2368 x 1568 pixels: 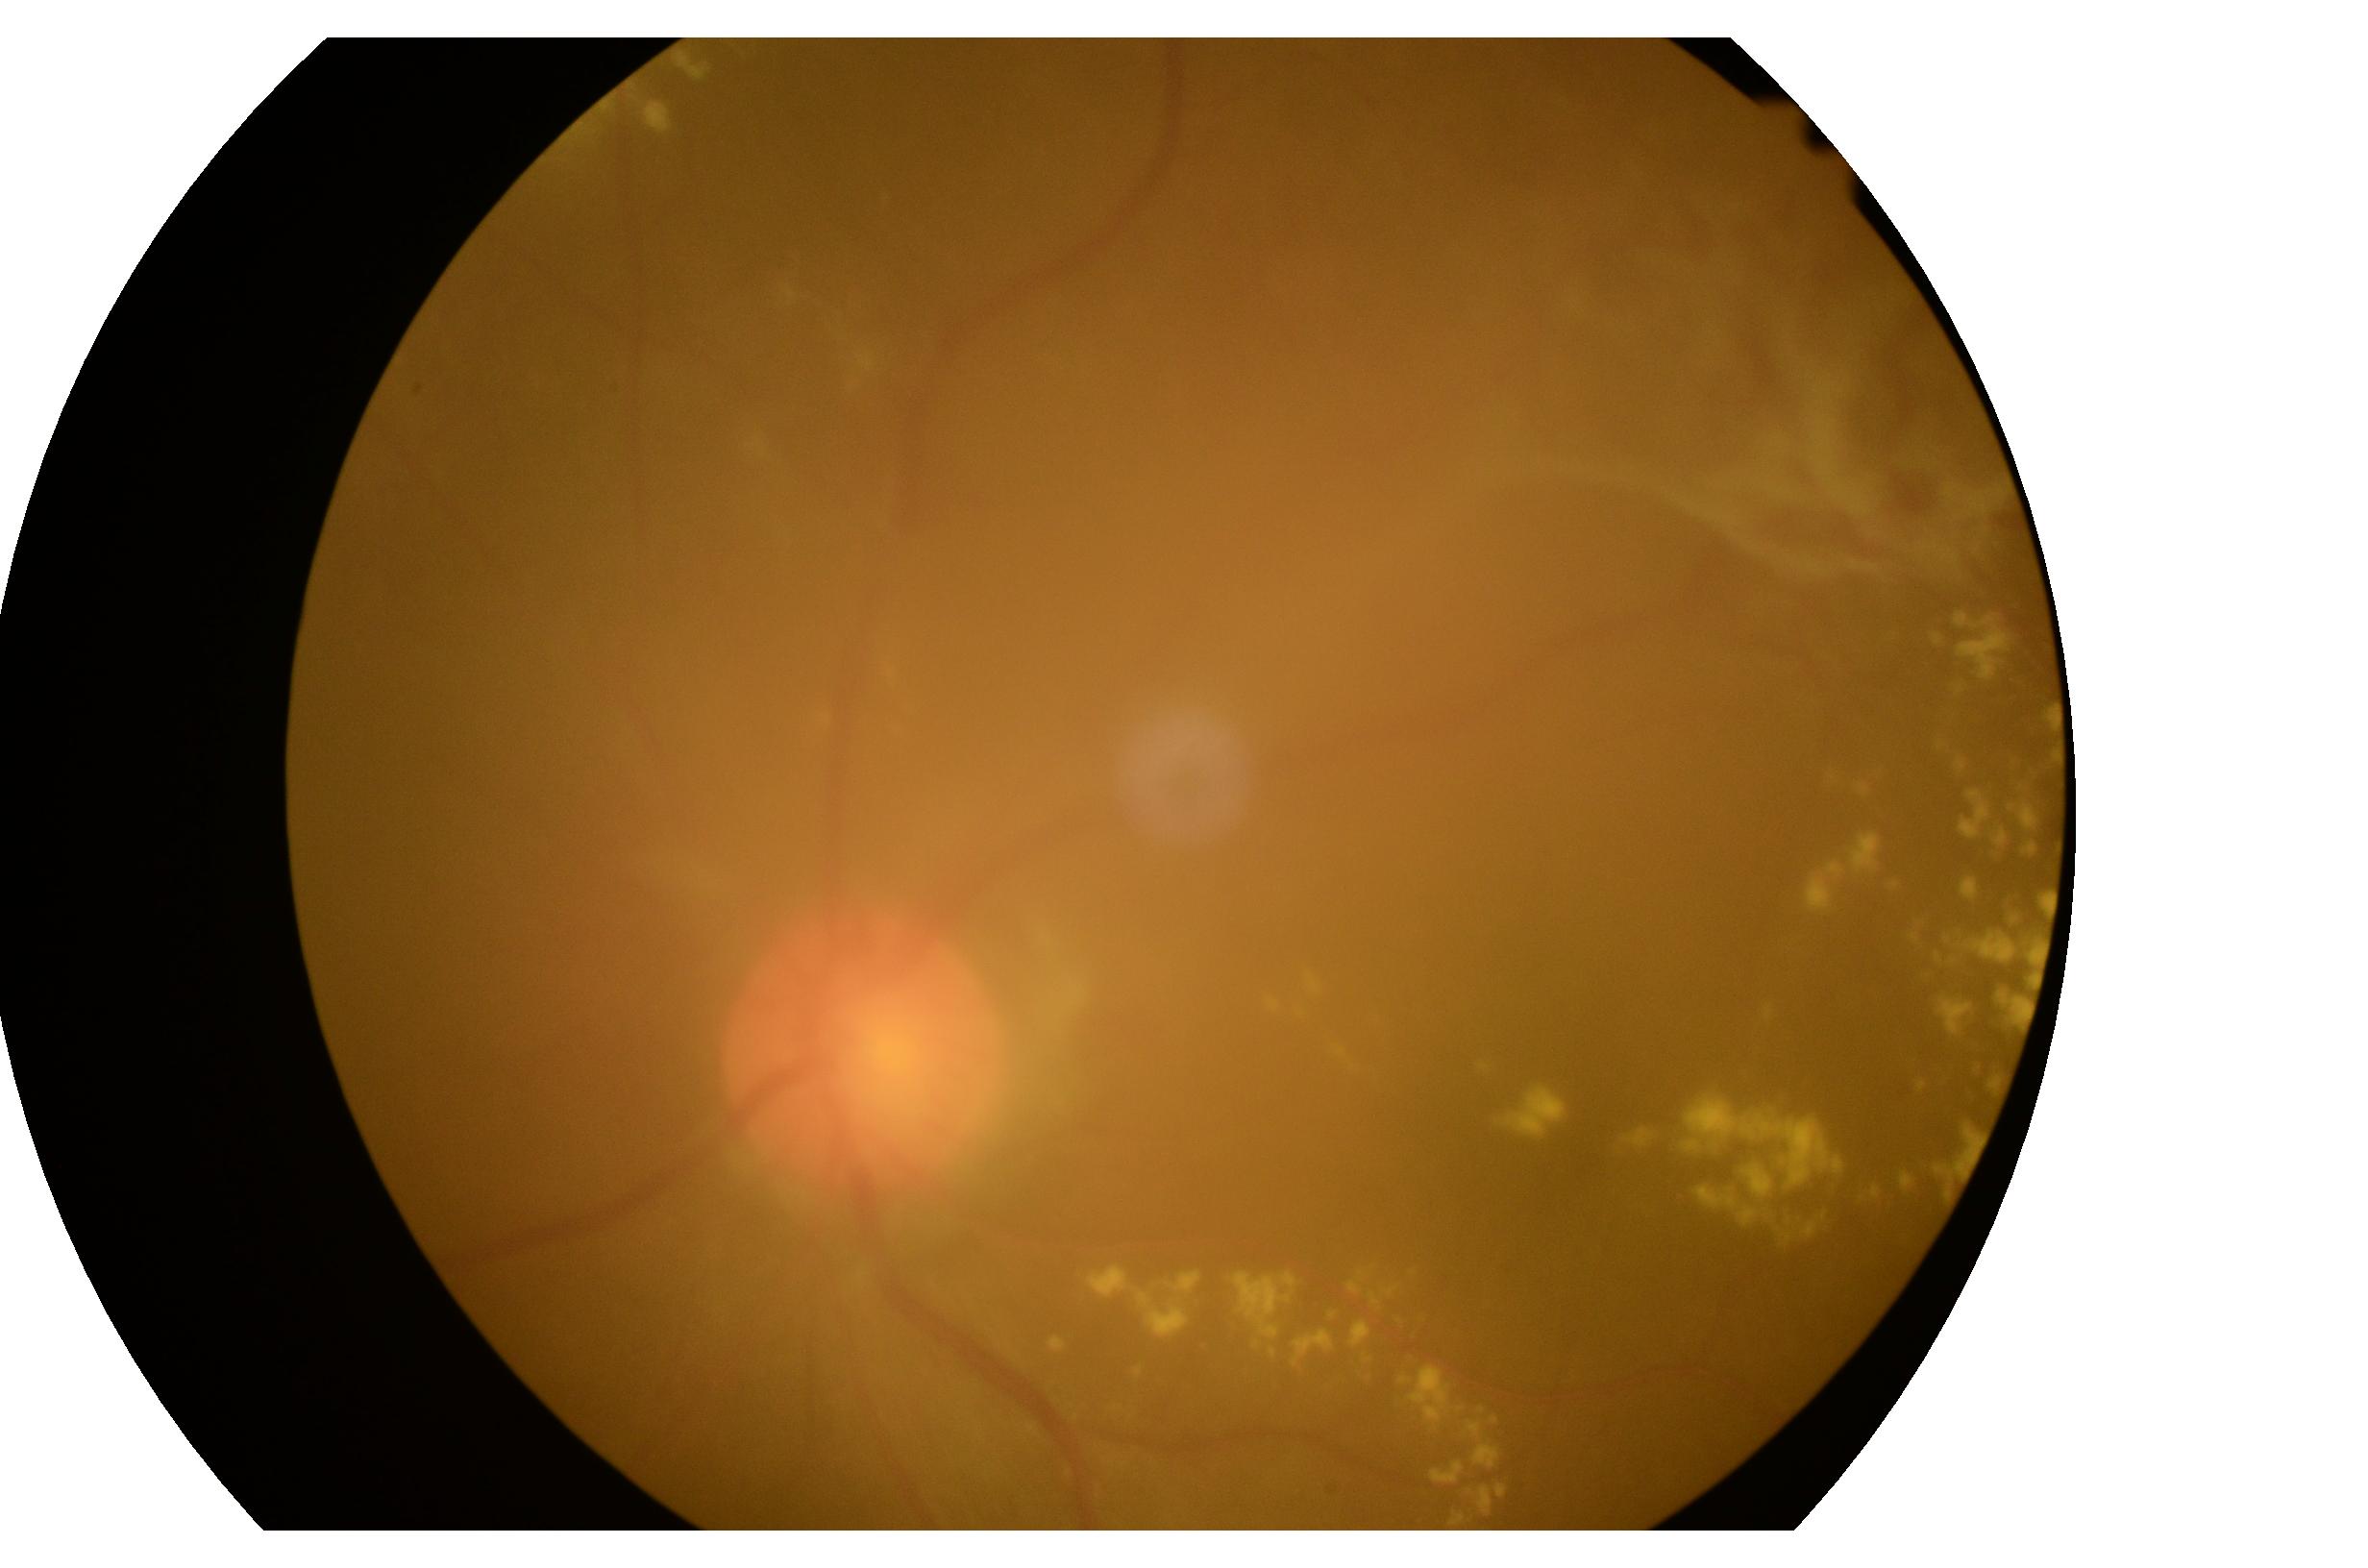

Findings:
• DR stage — grade 4
• DR class — proliferative diabetic retinopathy